FOV: 45 degrees · fundus photo · 1536 x 1152 pixels: 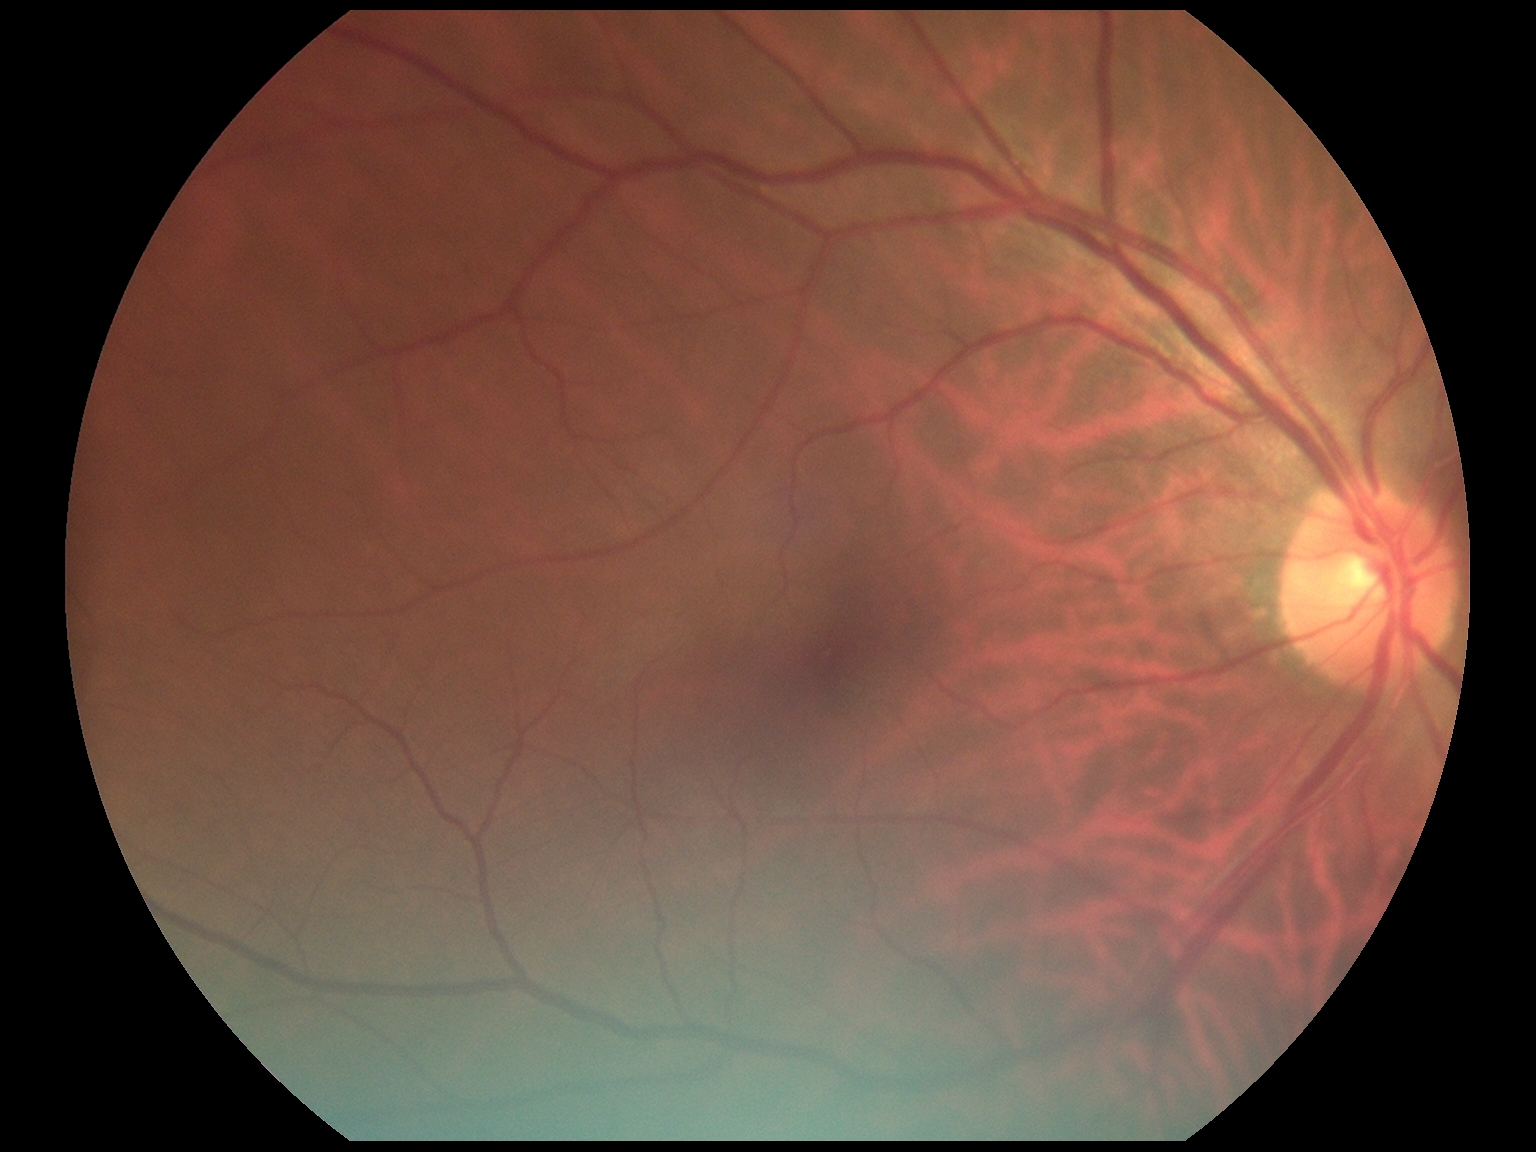

DR impression: negative for DR
diabetic retinopathy: grade 0 — no visible signs of diabetic retinopathy